Image size 1932x1932 — 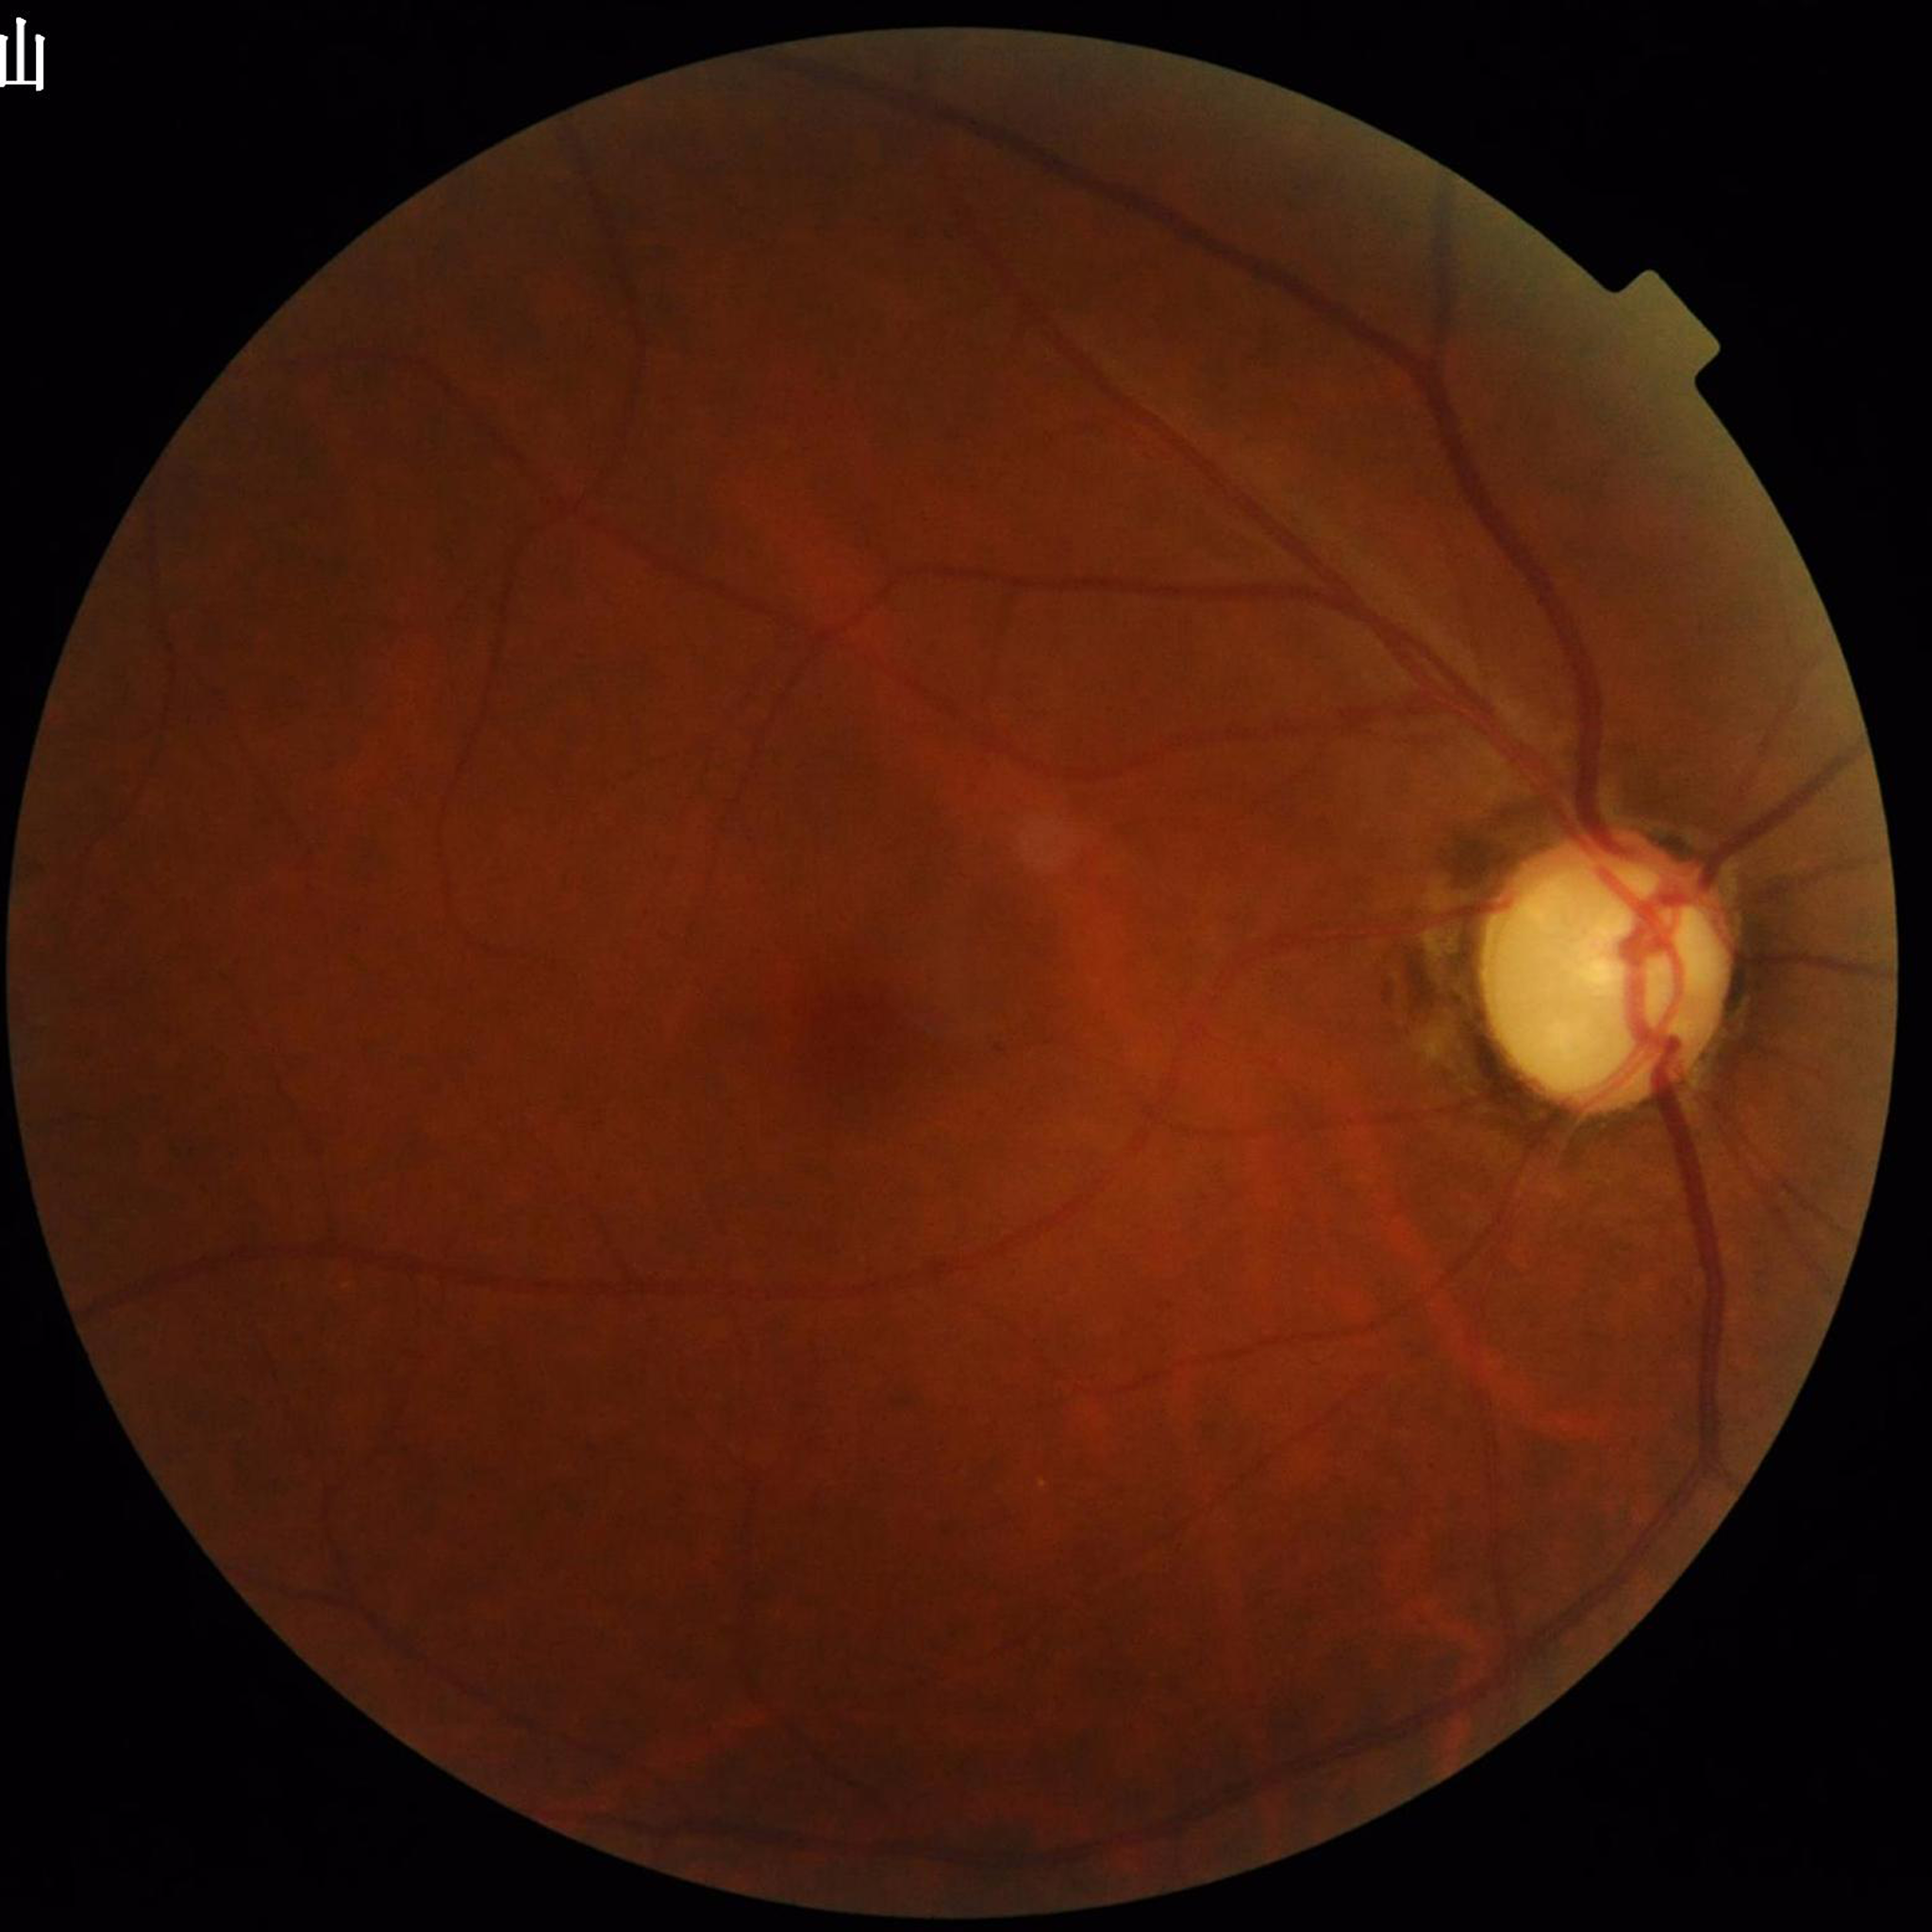

Color fundus photo. Patient diagnosed with glaucoma.